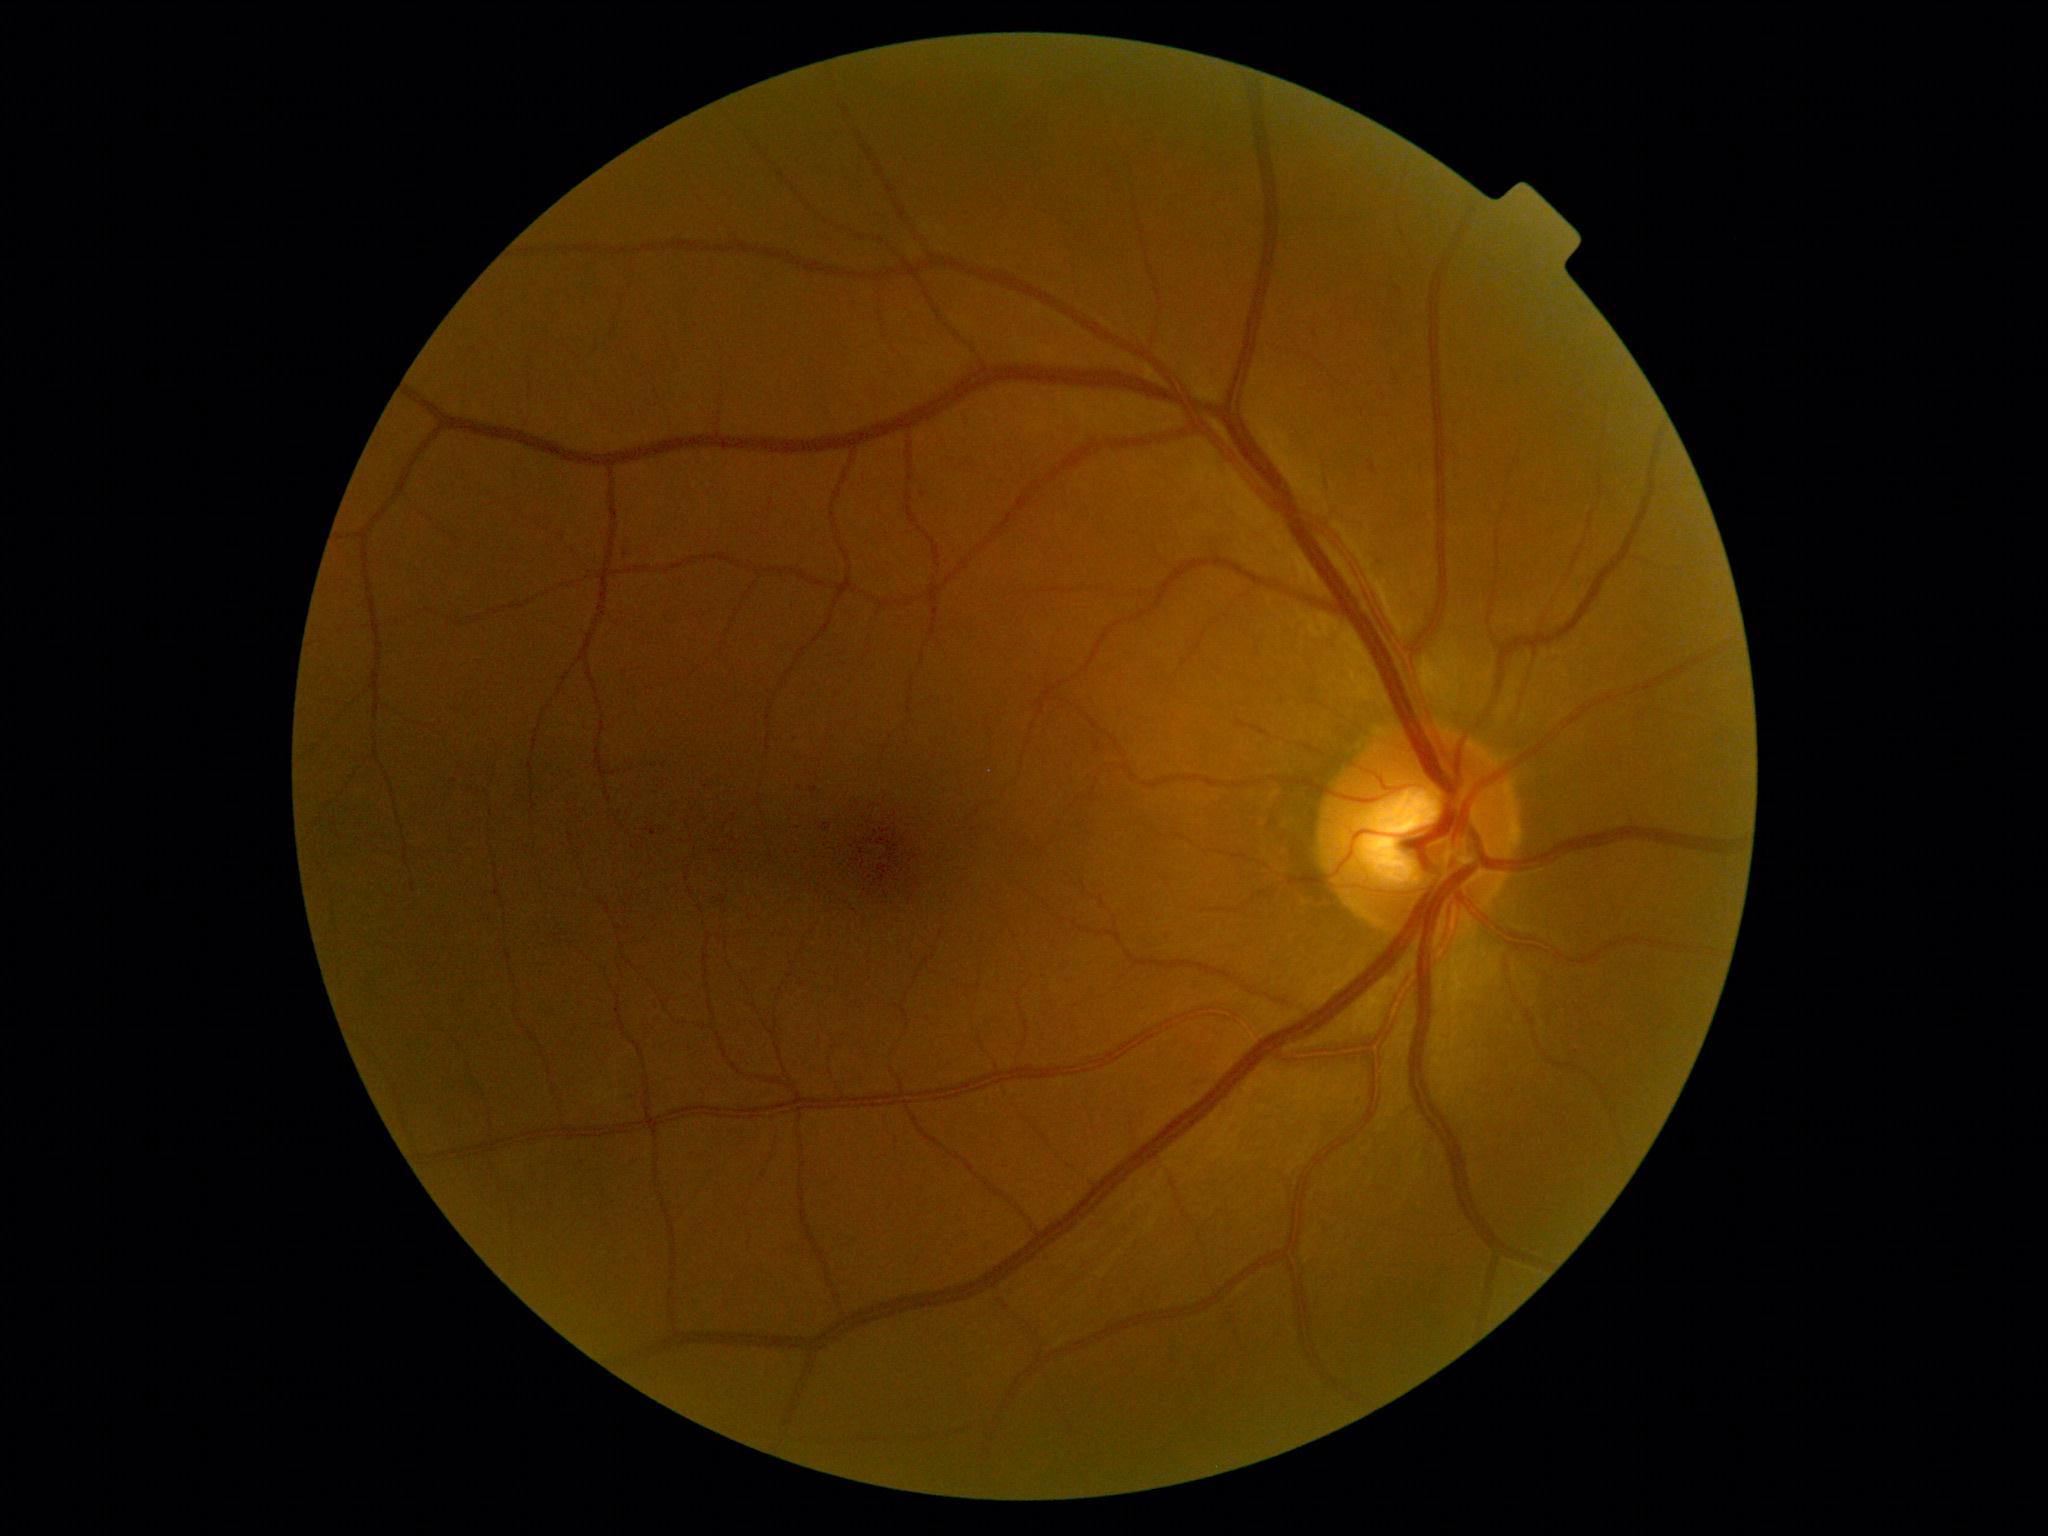

Diabetic retinopathy grade is 1 (mild NPDR).